Wide-field fundus photograph from neonatal ROP screening. 640x480px
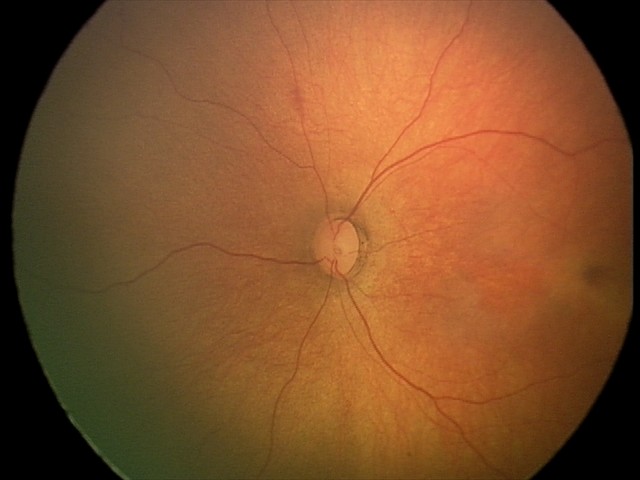
Physiological retinal appearance for postconceptual age.